Color fundus image — 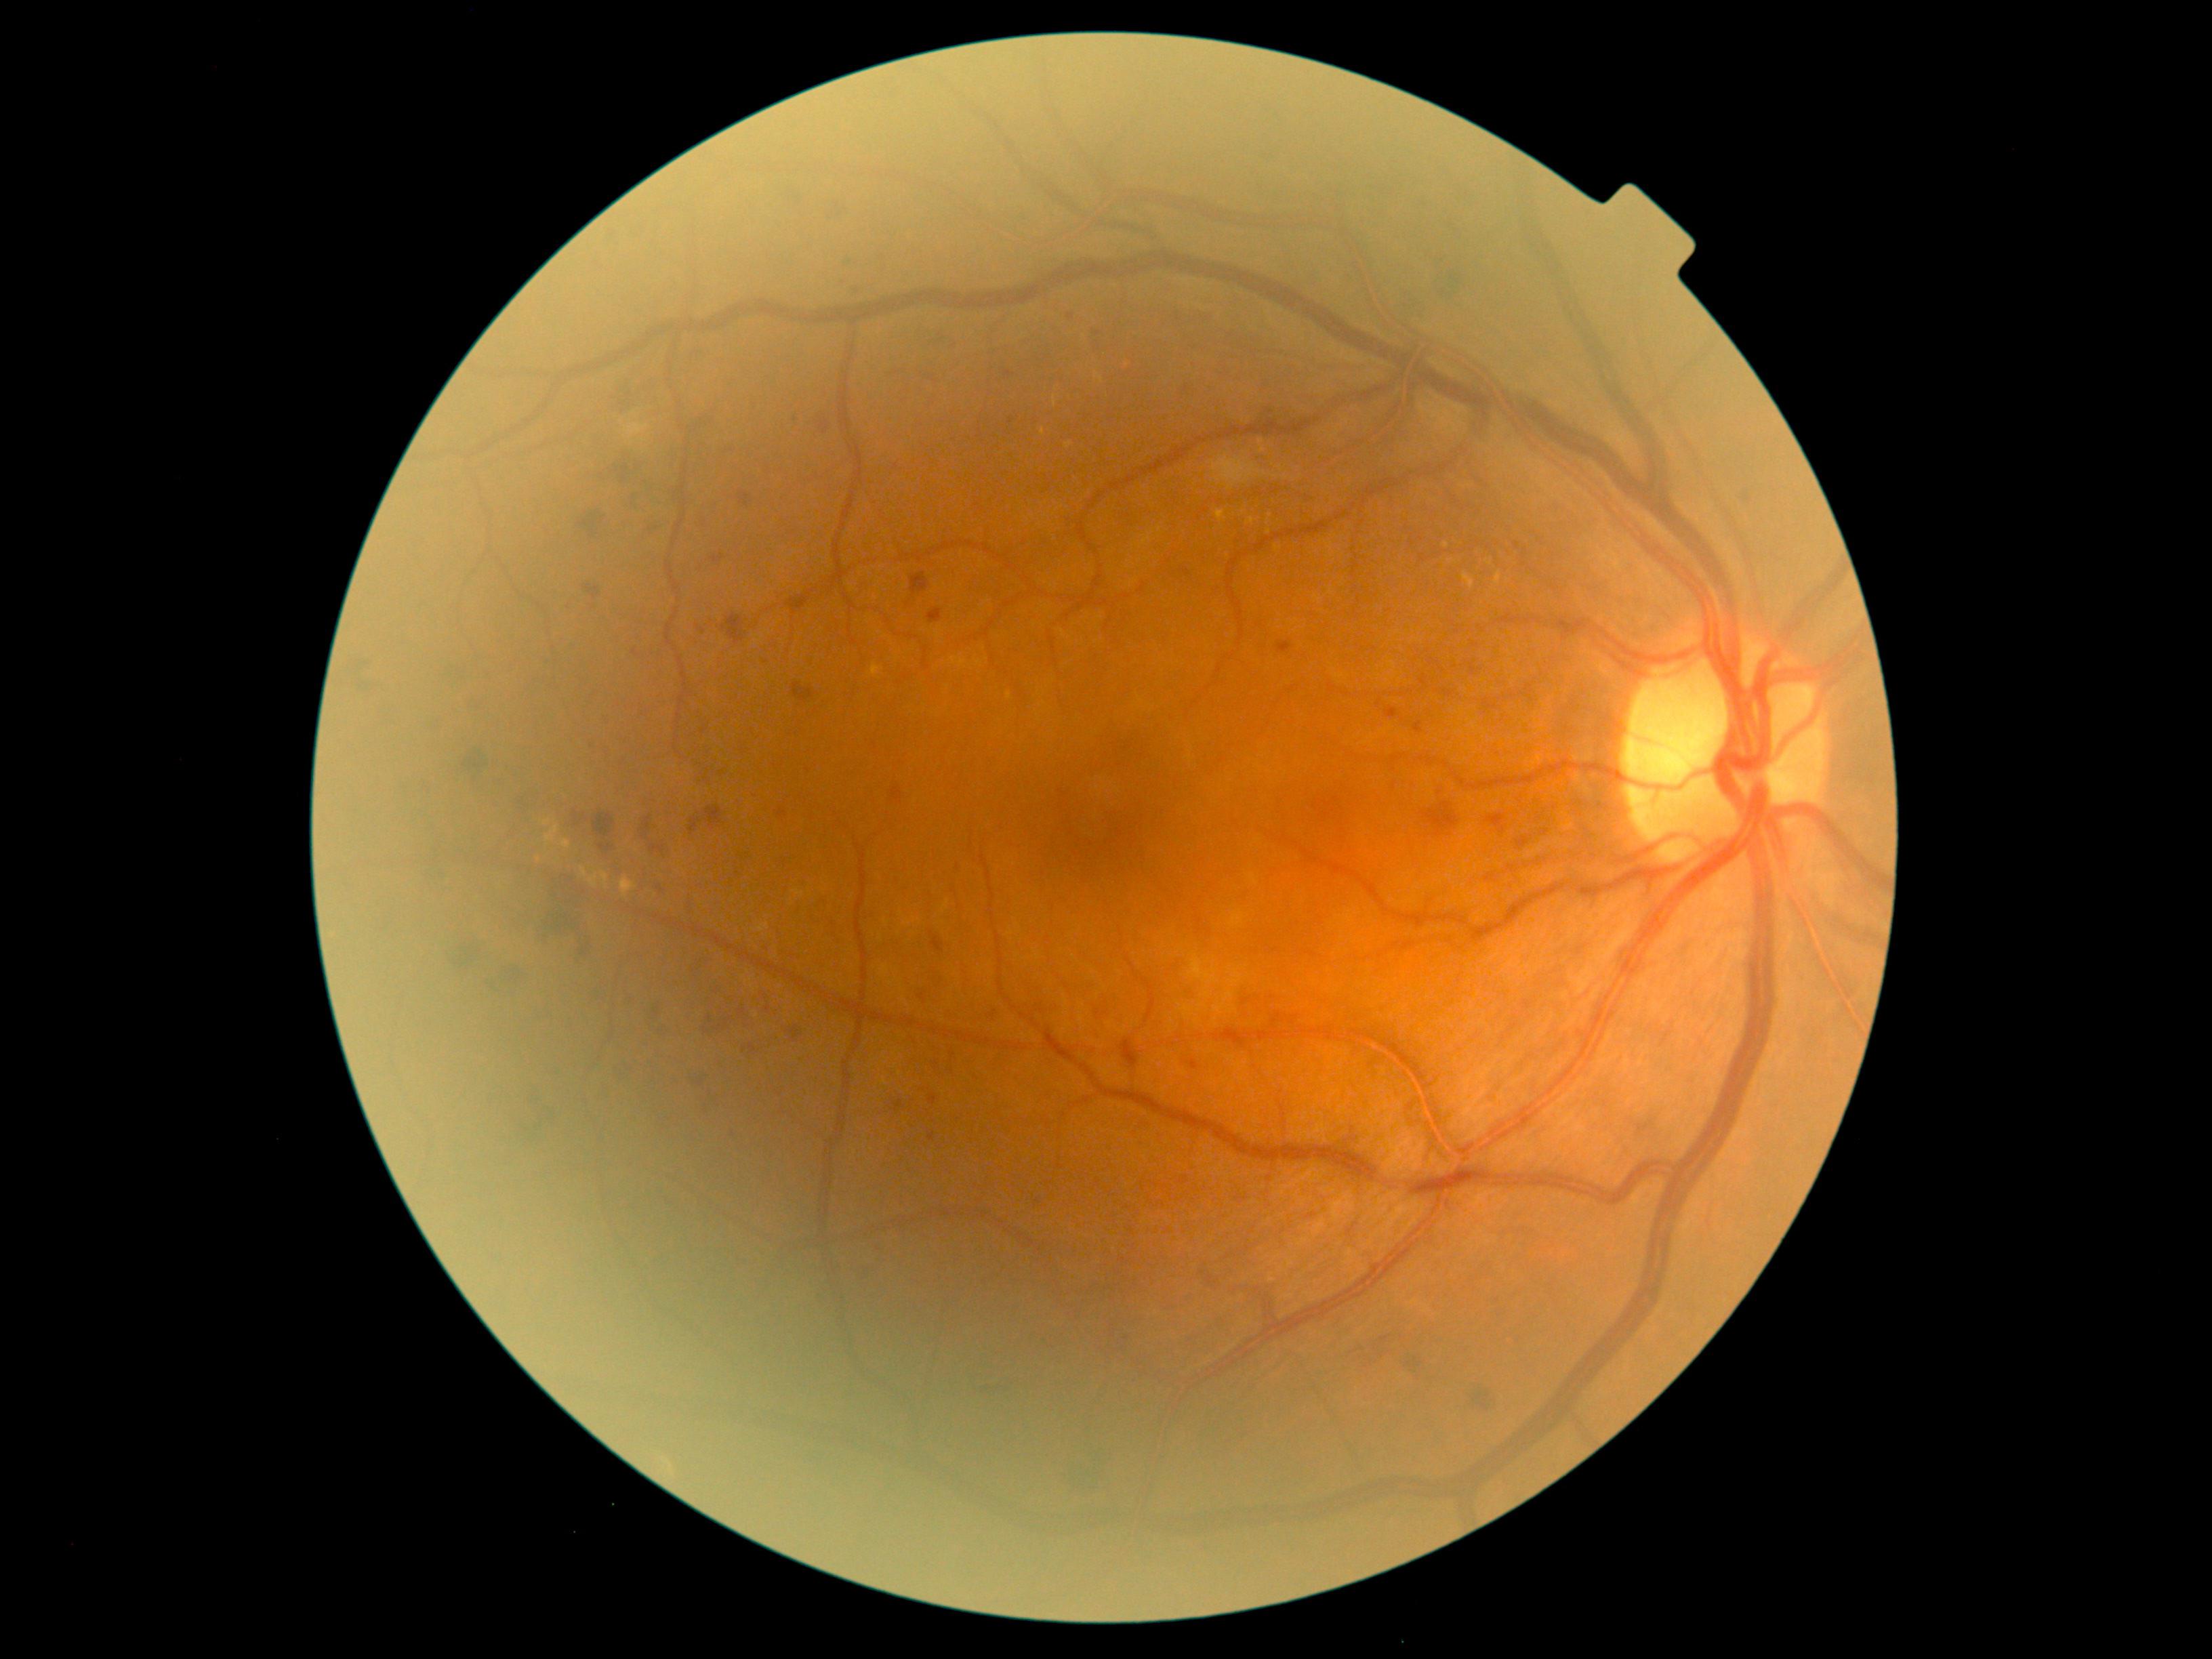
Diabetic retinopathy (DR) is severe NPDR (grade 3) — more than 20 intraretinal hemorrhages in each of 4 quadrants, definite venous beading in 2 or more quadrants, or prominent intraretinal microvascular abnormalities in 1 or more quadrants, with no signs of proliferative retinopathy.